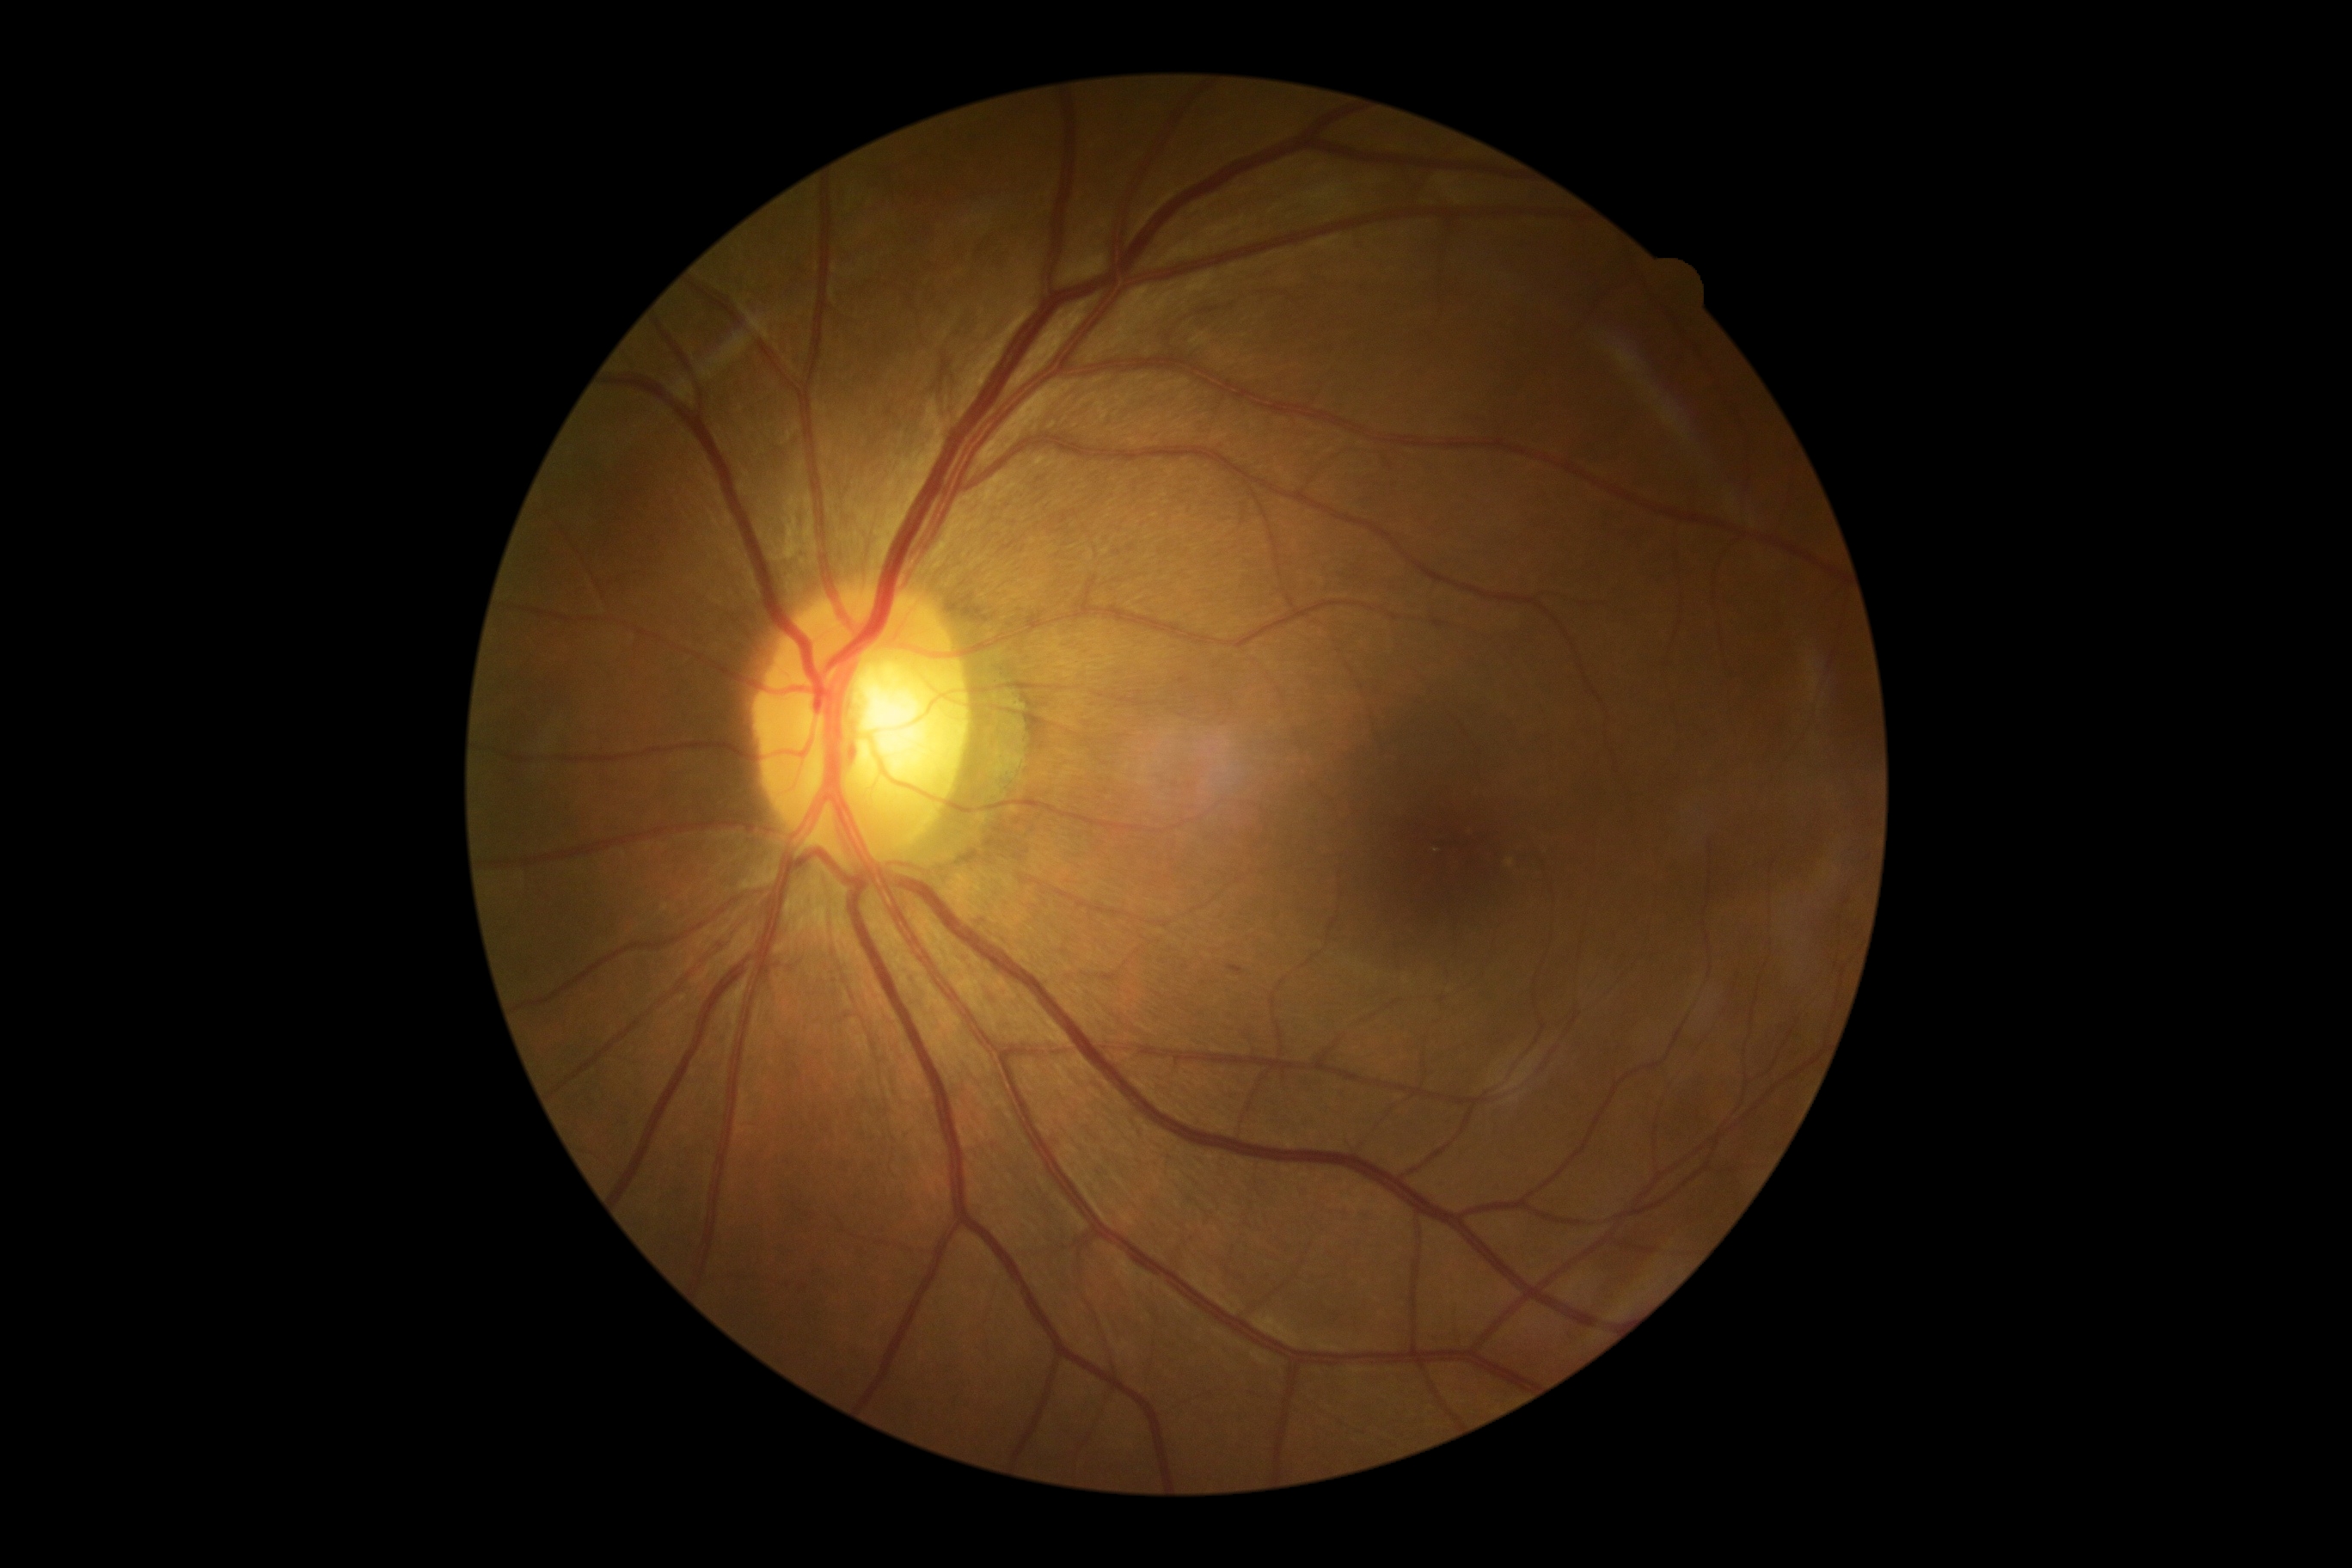 dr_grade: grade 1 (mild NPDR)